45-degree field of view, color fundus photograph:
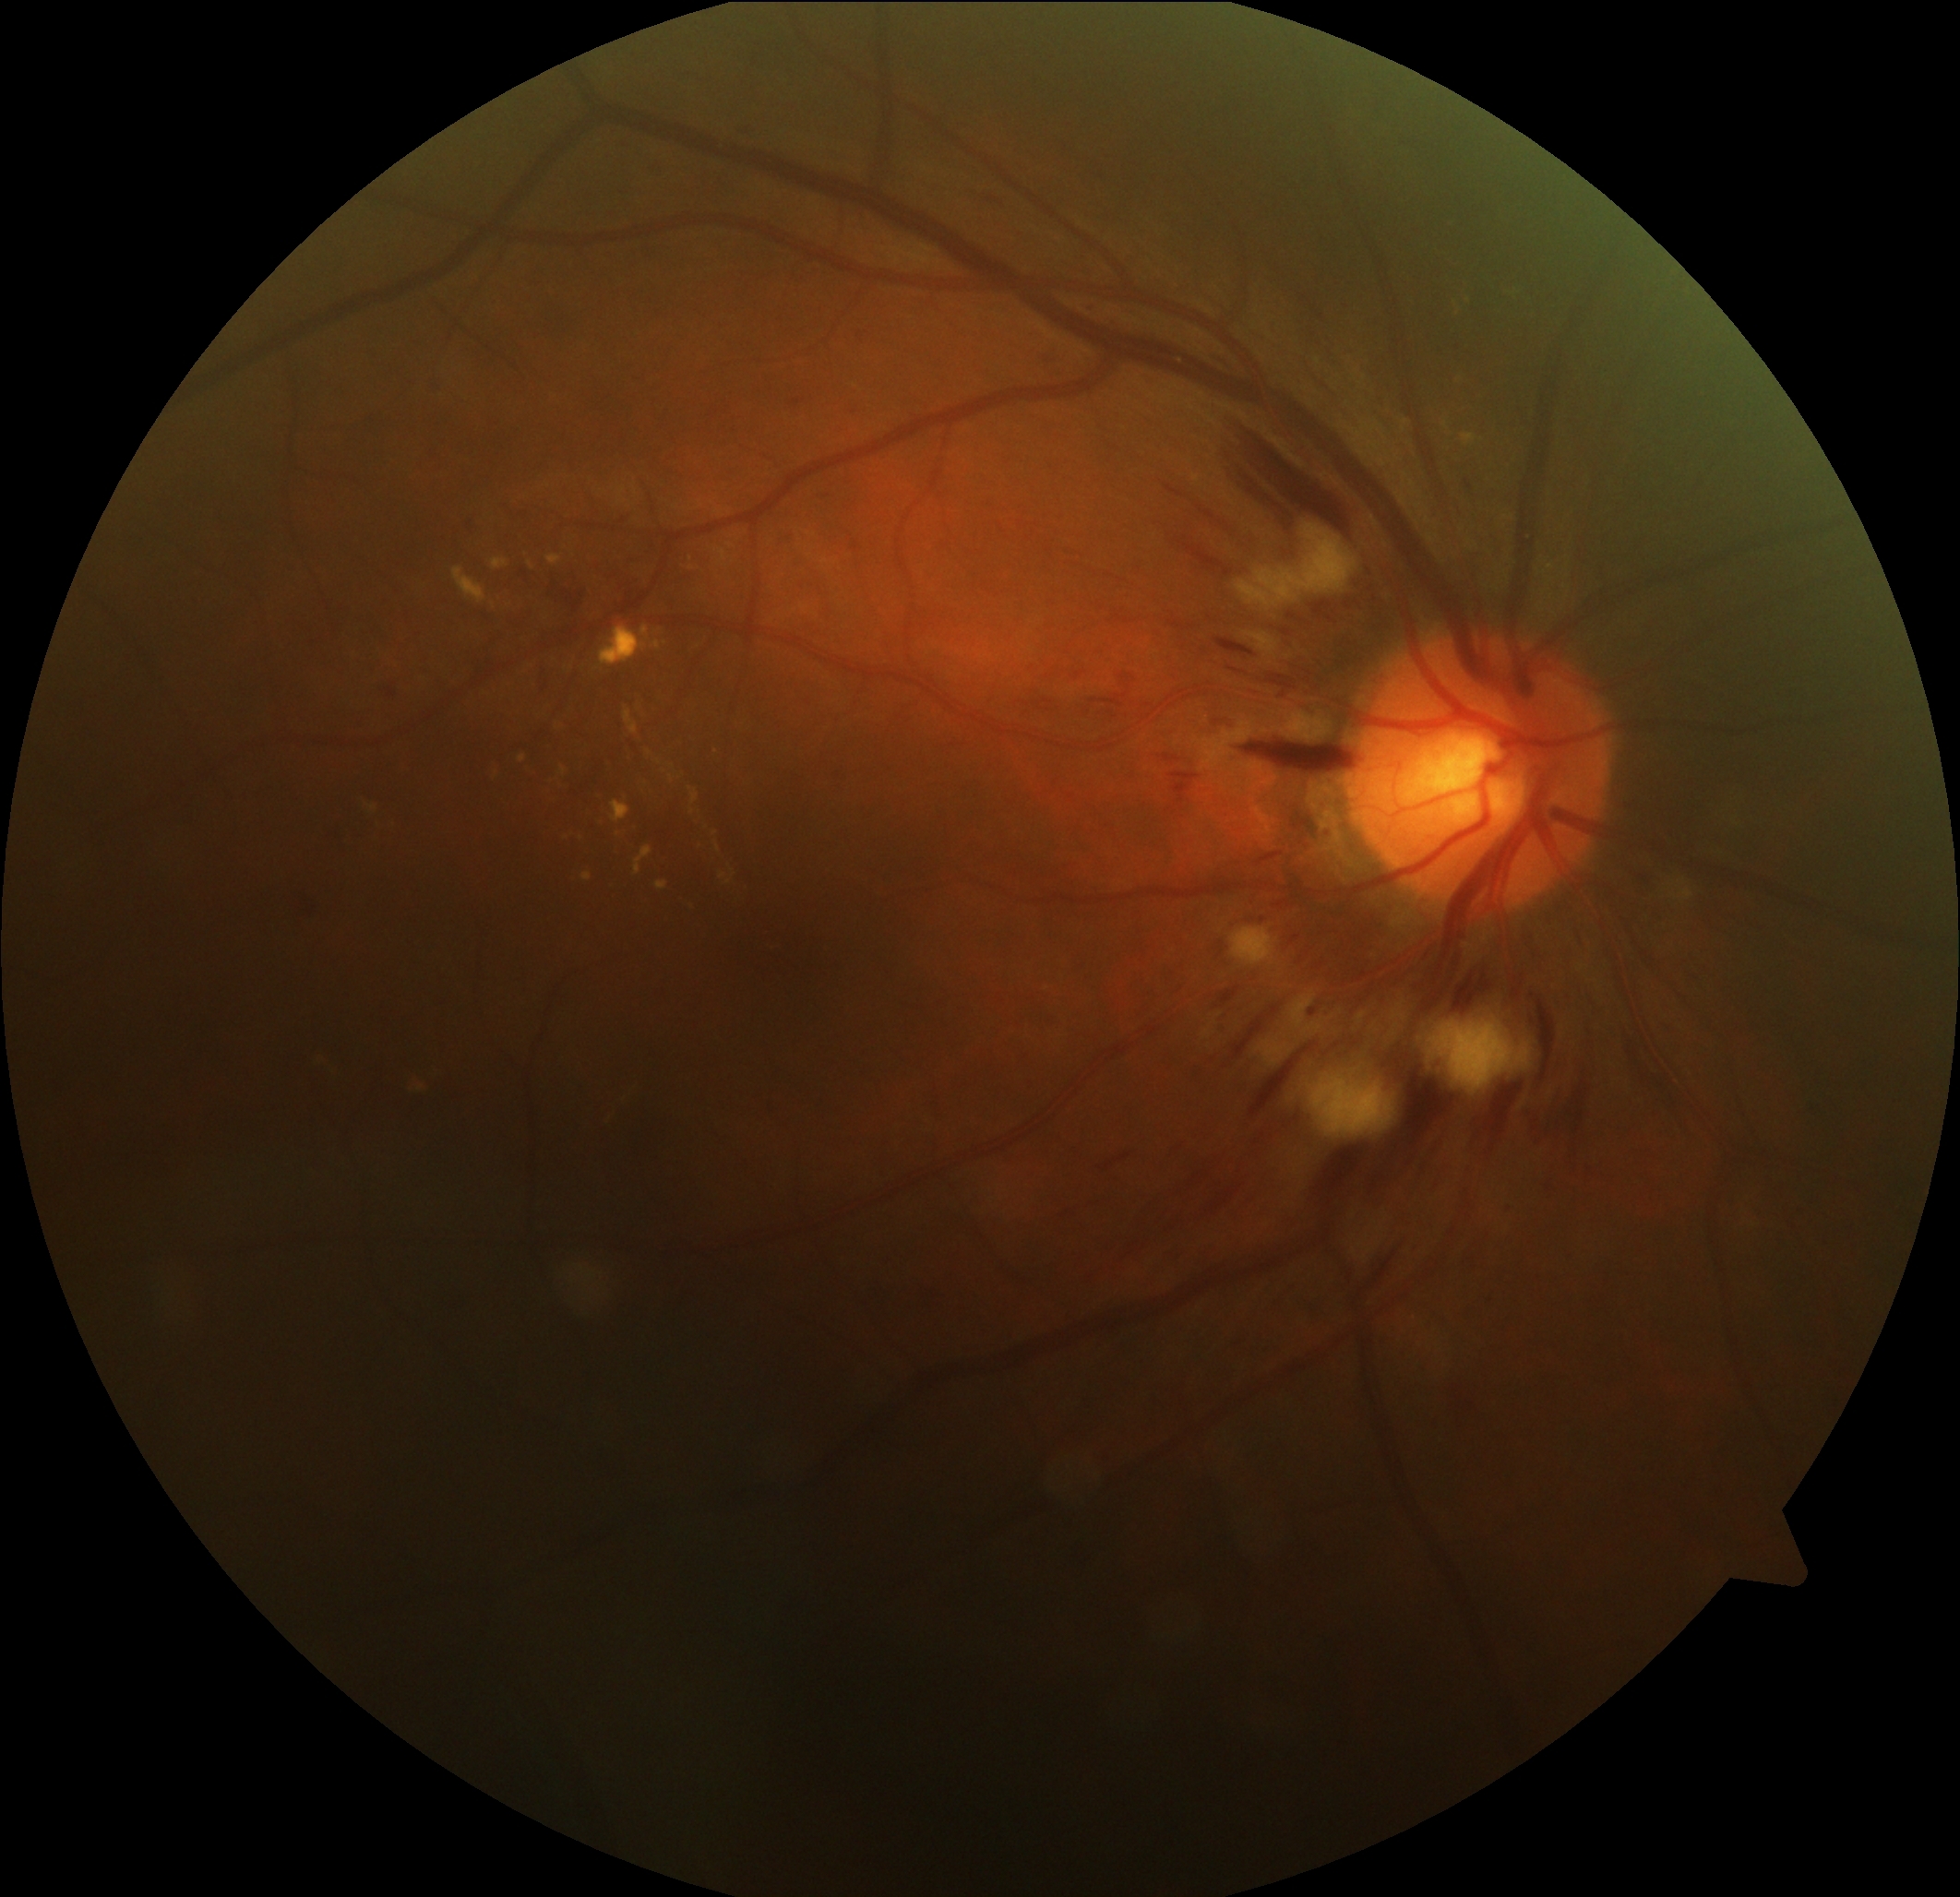

- DR stage — grade 2